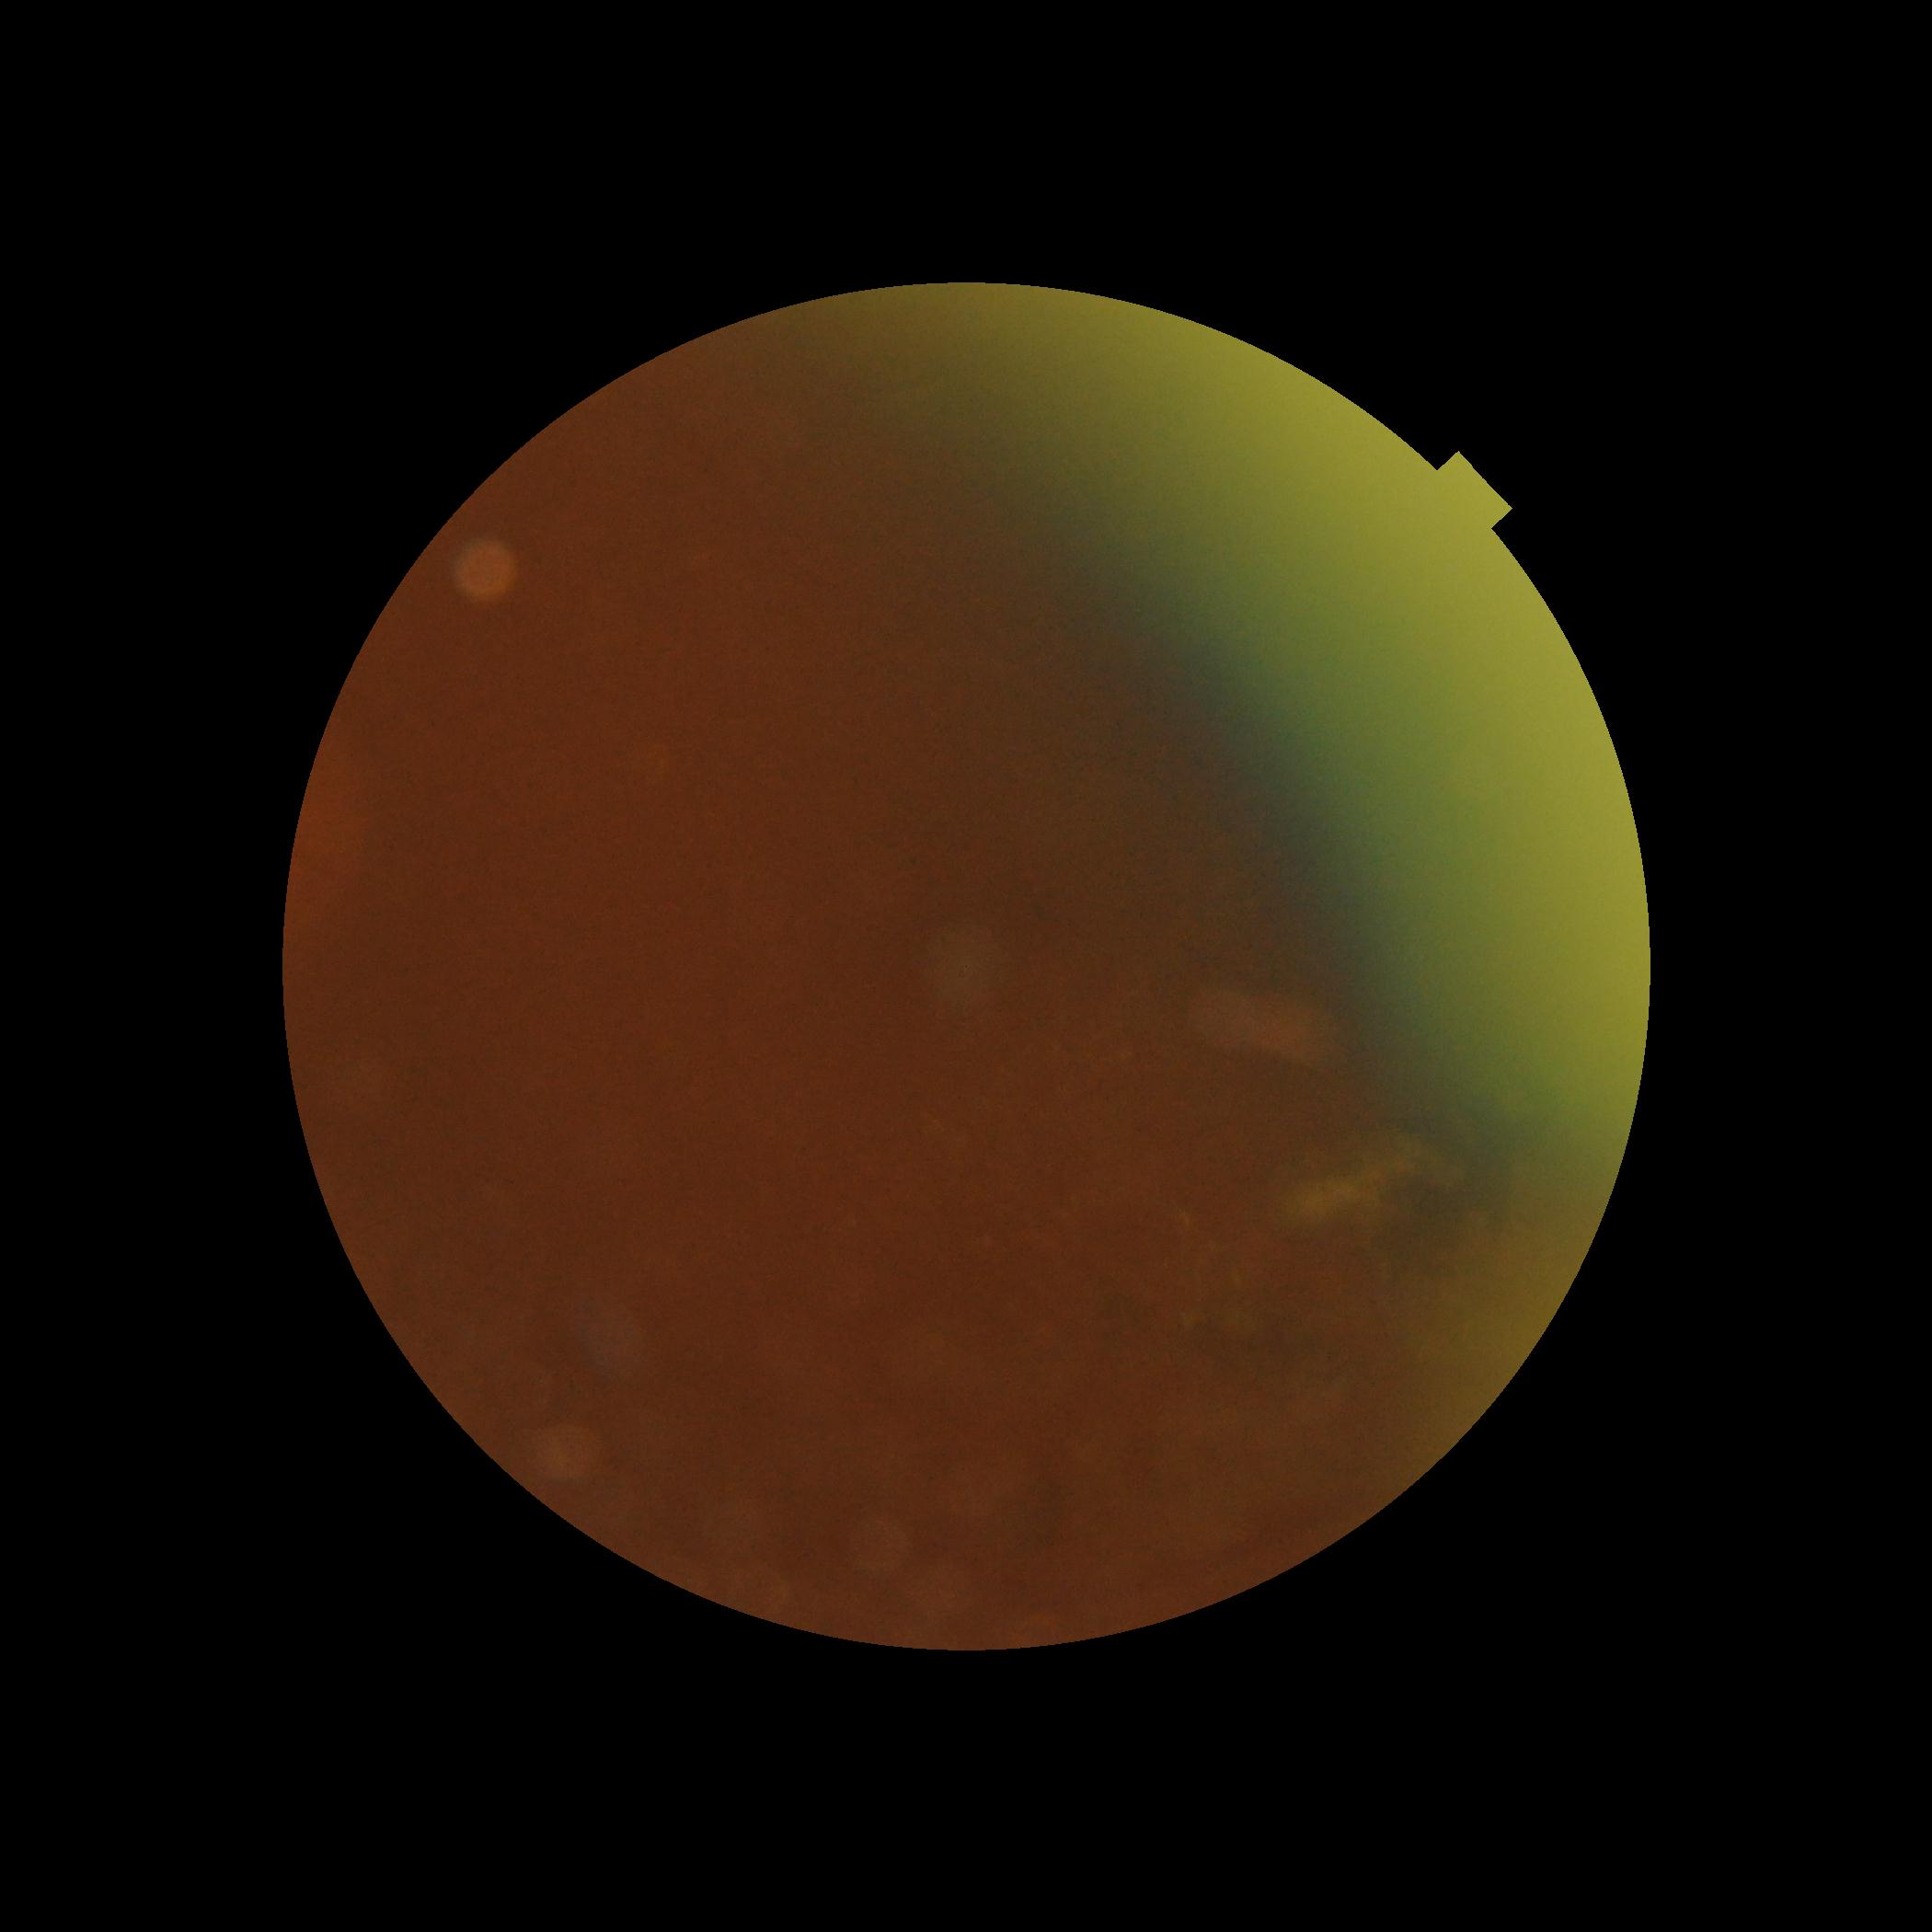

DR: ungradable.